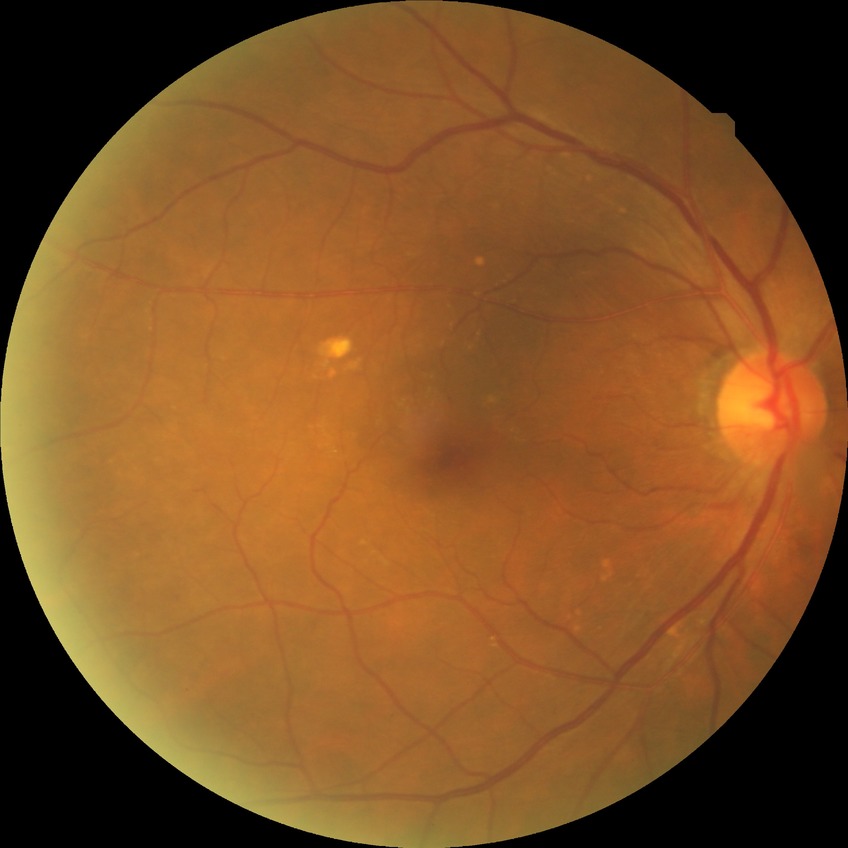
Diabetic retinopathy (DR): no diabetic retinopathy (NDR).